Camera: Forus 3Nethra Classic; color fundus photograph; image size 2048x1536
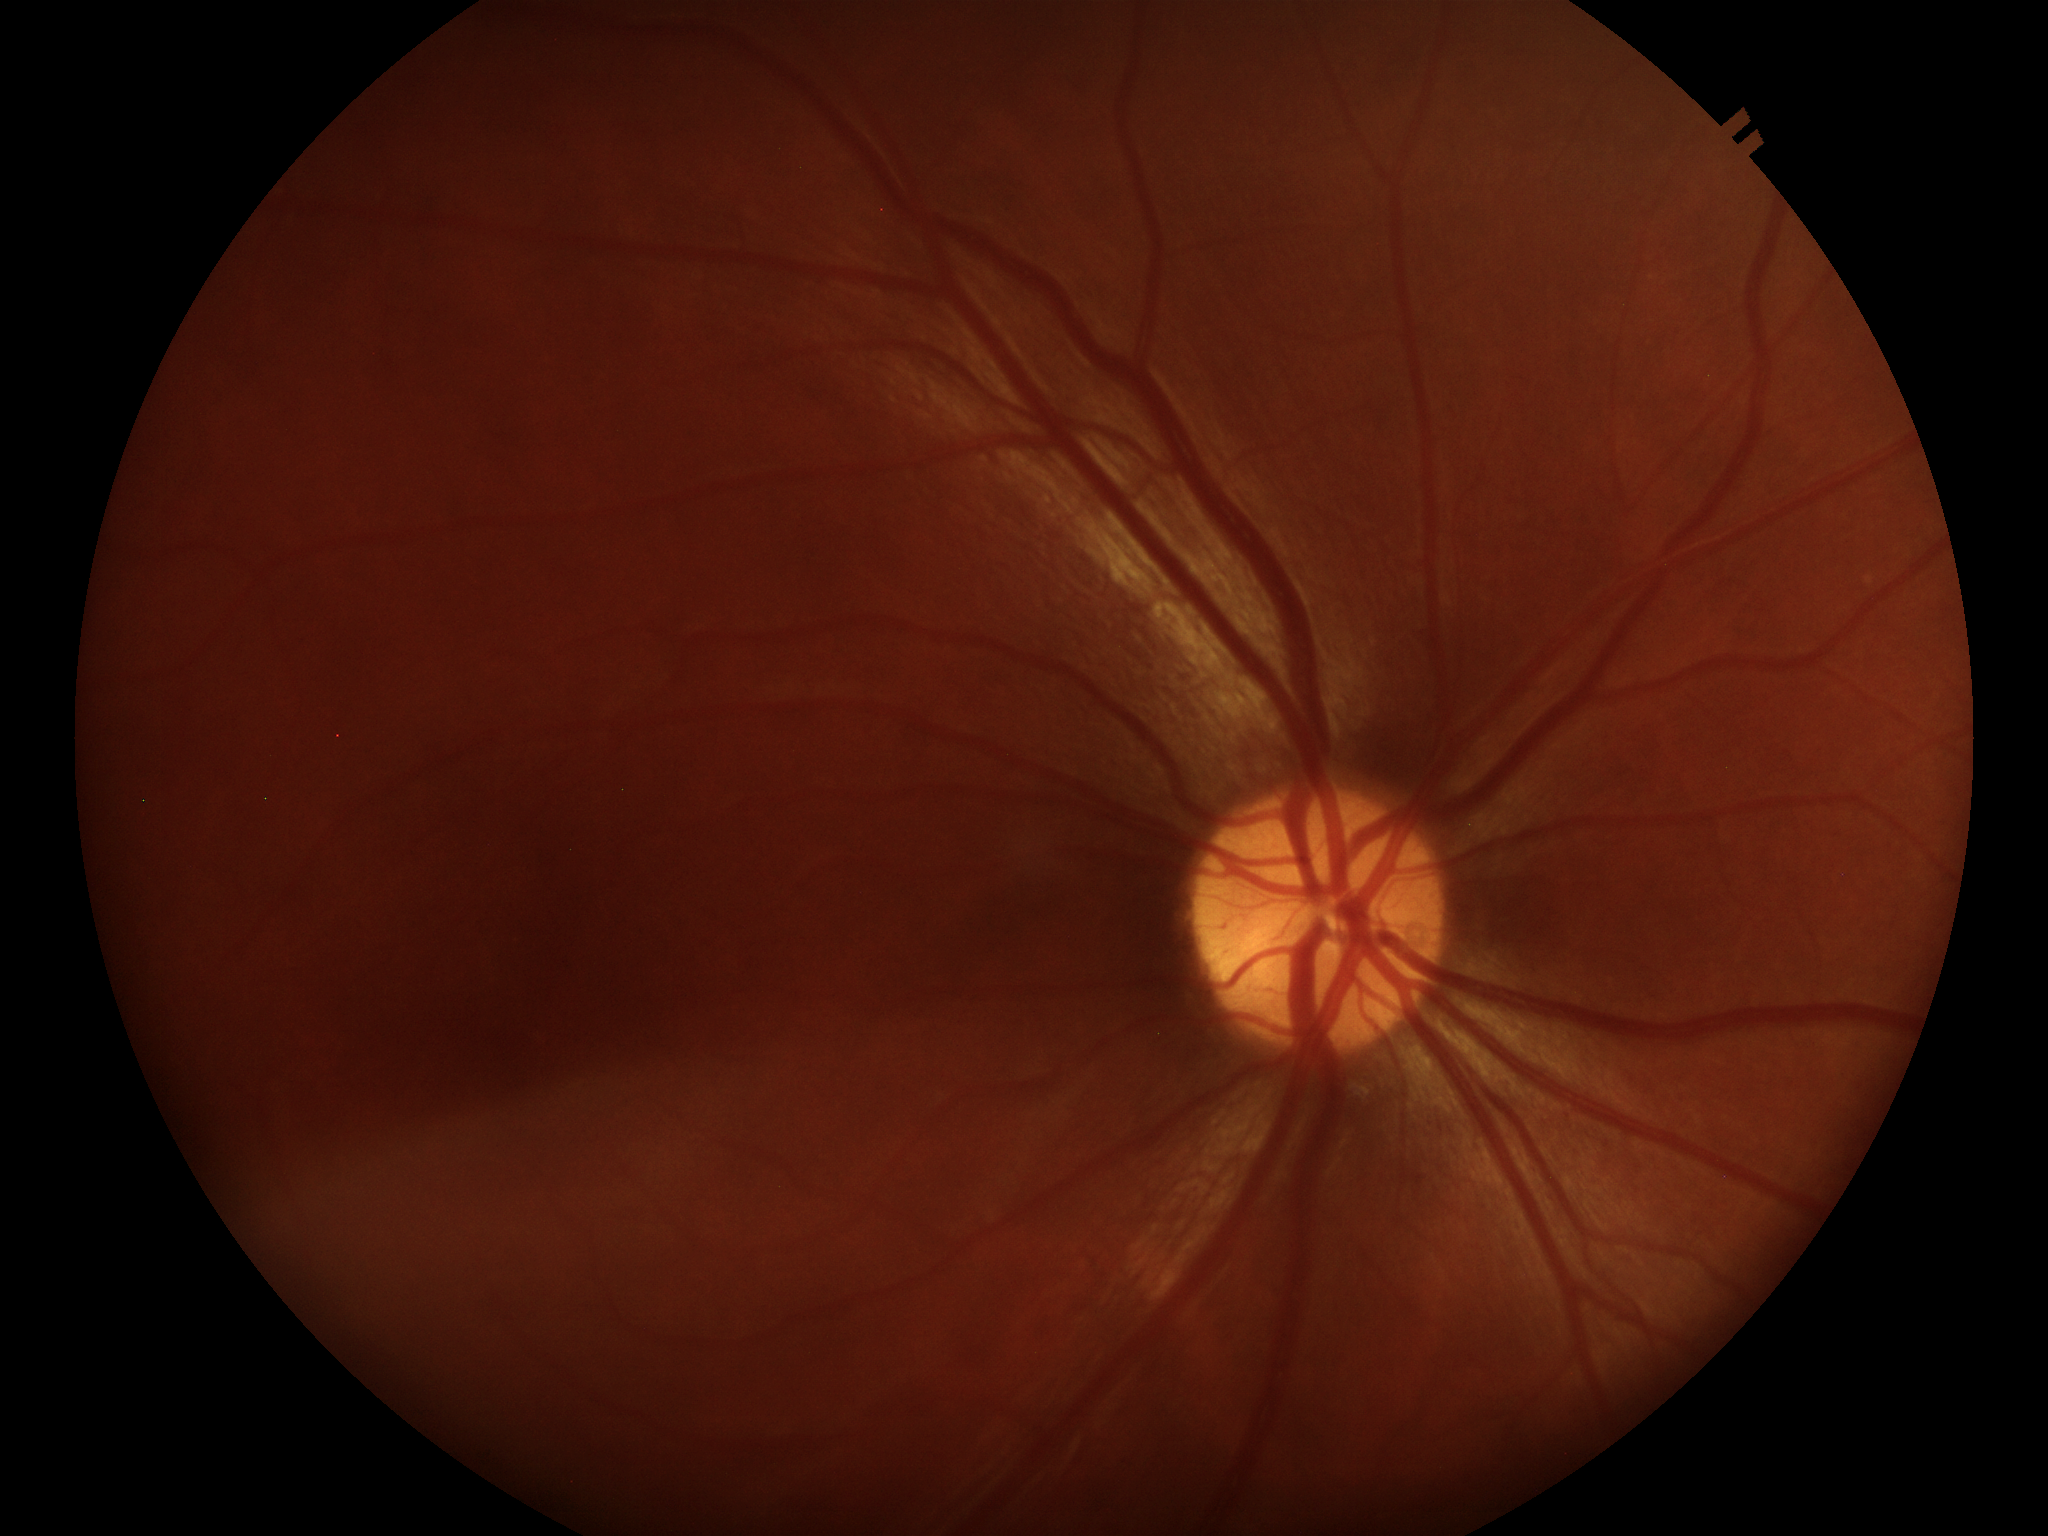
horizontal cup-disc ratio (HCDR) = 0.46 | Glaucoma assessment = no suspicious findings | vertical cup-disc ratio (VCDR) = 0.47.